Pediatric wide-field fundus photograph:
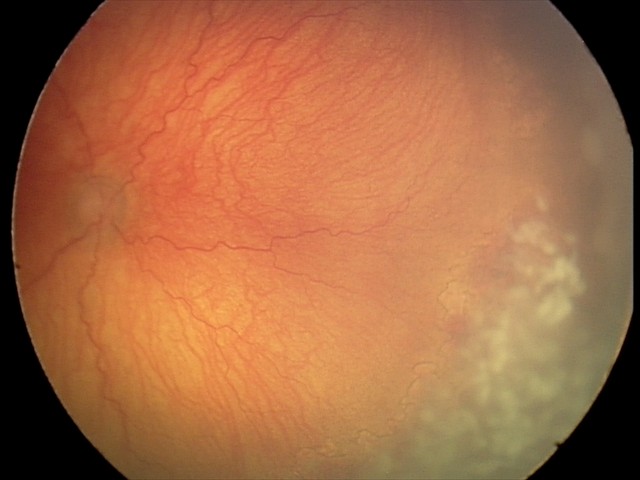

Plus disease present. Screening series with aggressive ROP (A-ROP) — rapidly progressive severe ROP with prominent plus disease, often without classic stage progression.